Disc-centered fundus crop:
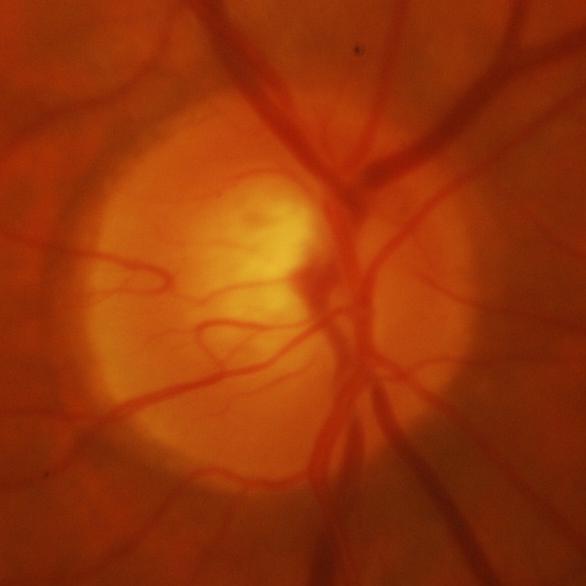

Glaucomatous changes are present. Assessment = evidence of glaucoma.